Color fundus image: 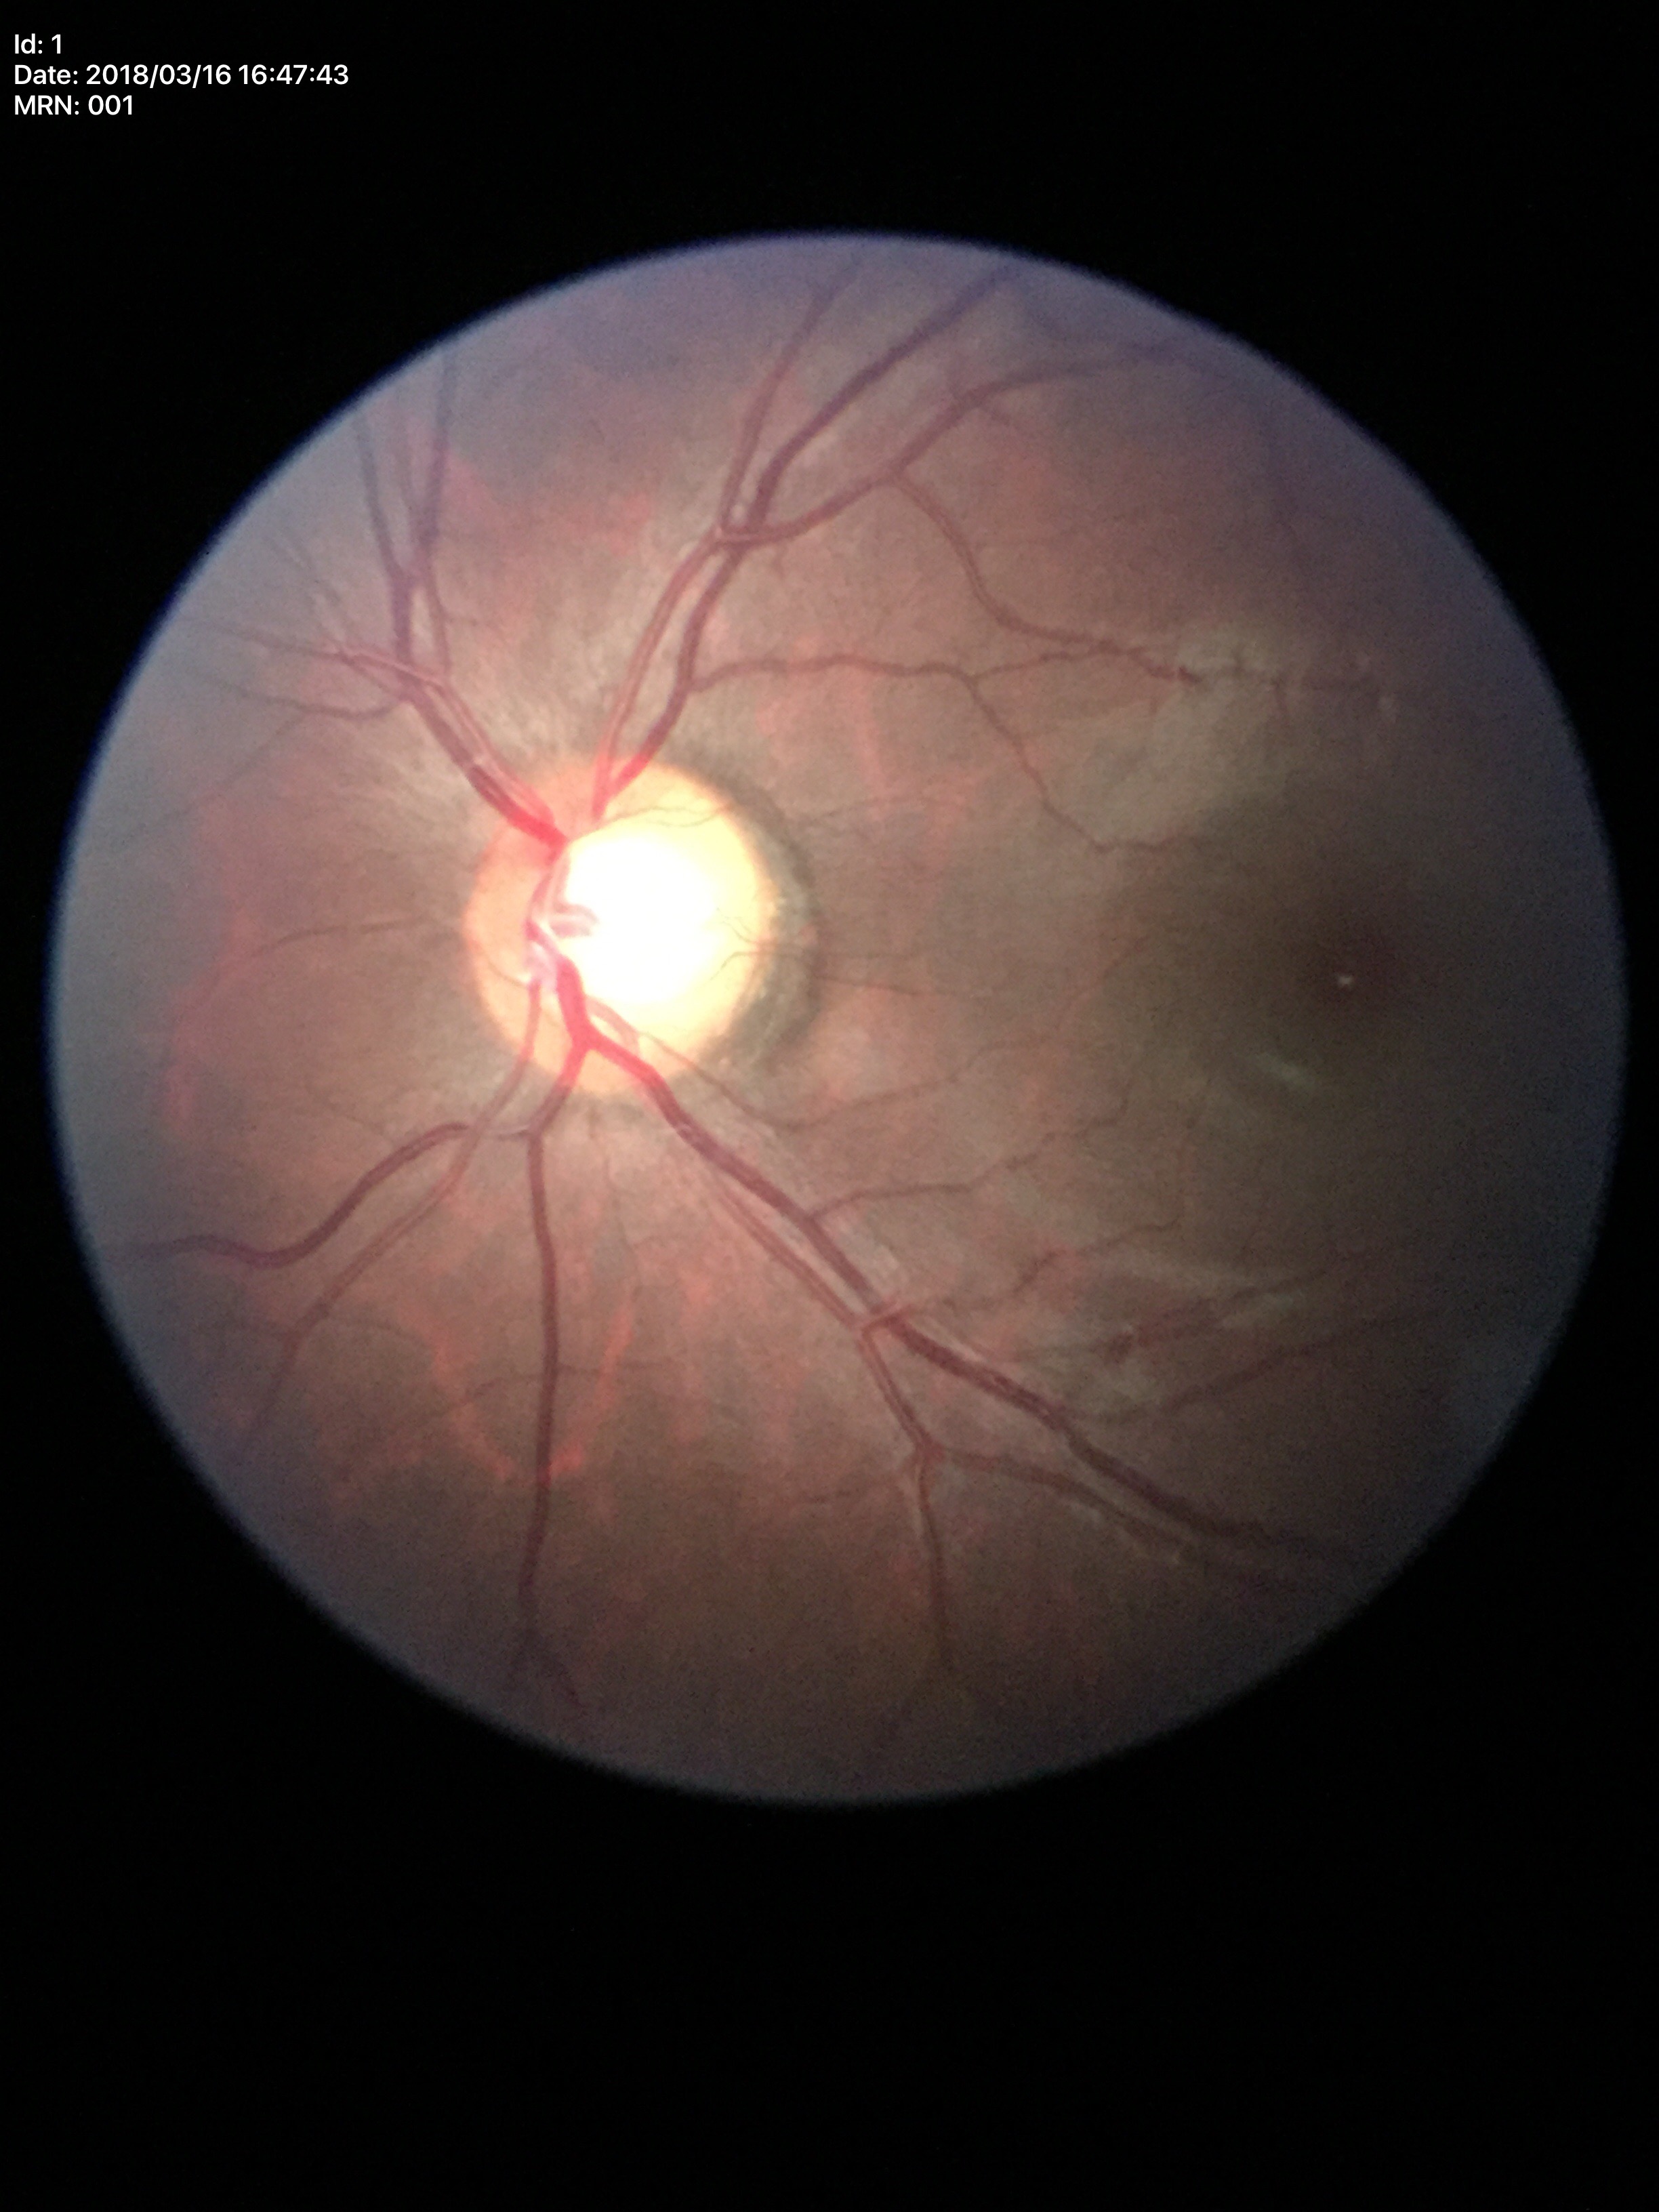 Horizontal cup-disc ratio of 0.67.
Glaucoma screening impression: suspicious (5/5 ophthalmologists in agreement).
Vertical CDR: 0.69.